Infant wide-field retinal image · 100° field of view (Phoenix ICON) — 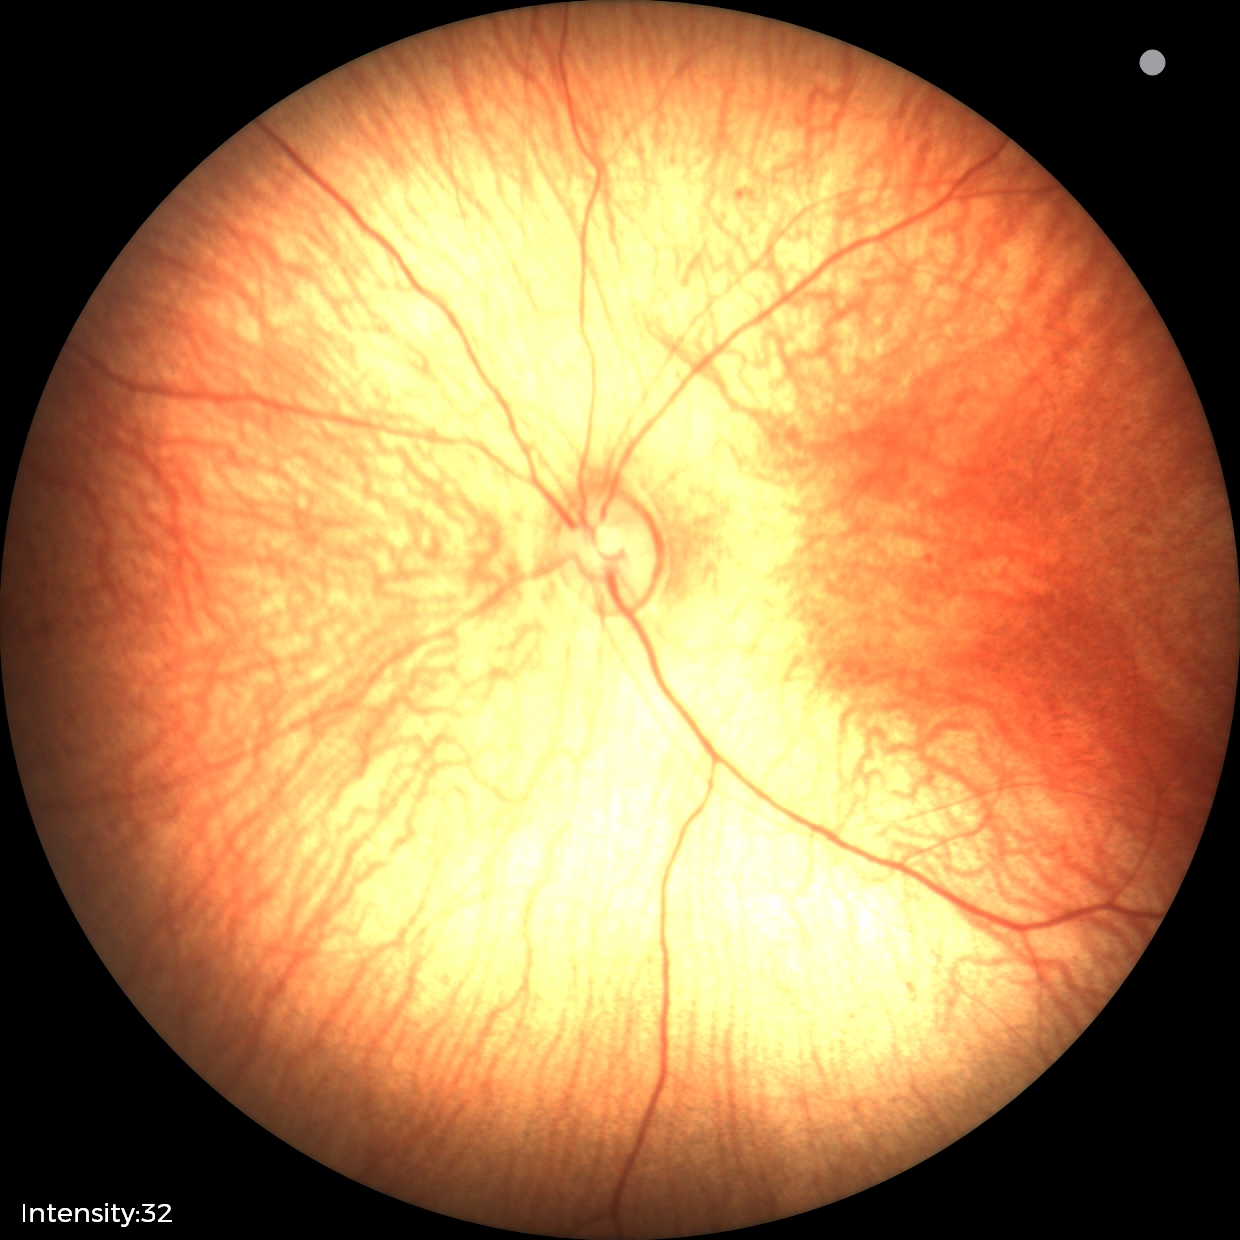 Physiological retinal appearance for postconceptual age.